Wide-field fundus photograph of an infant: 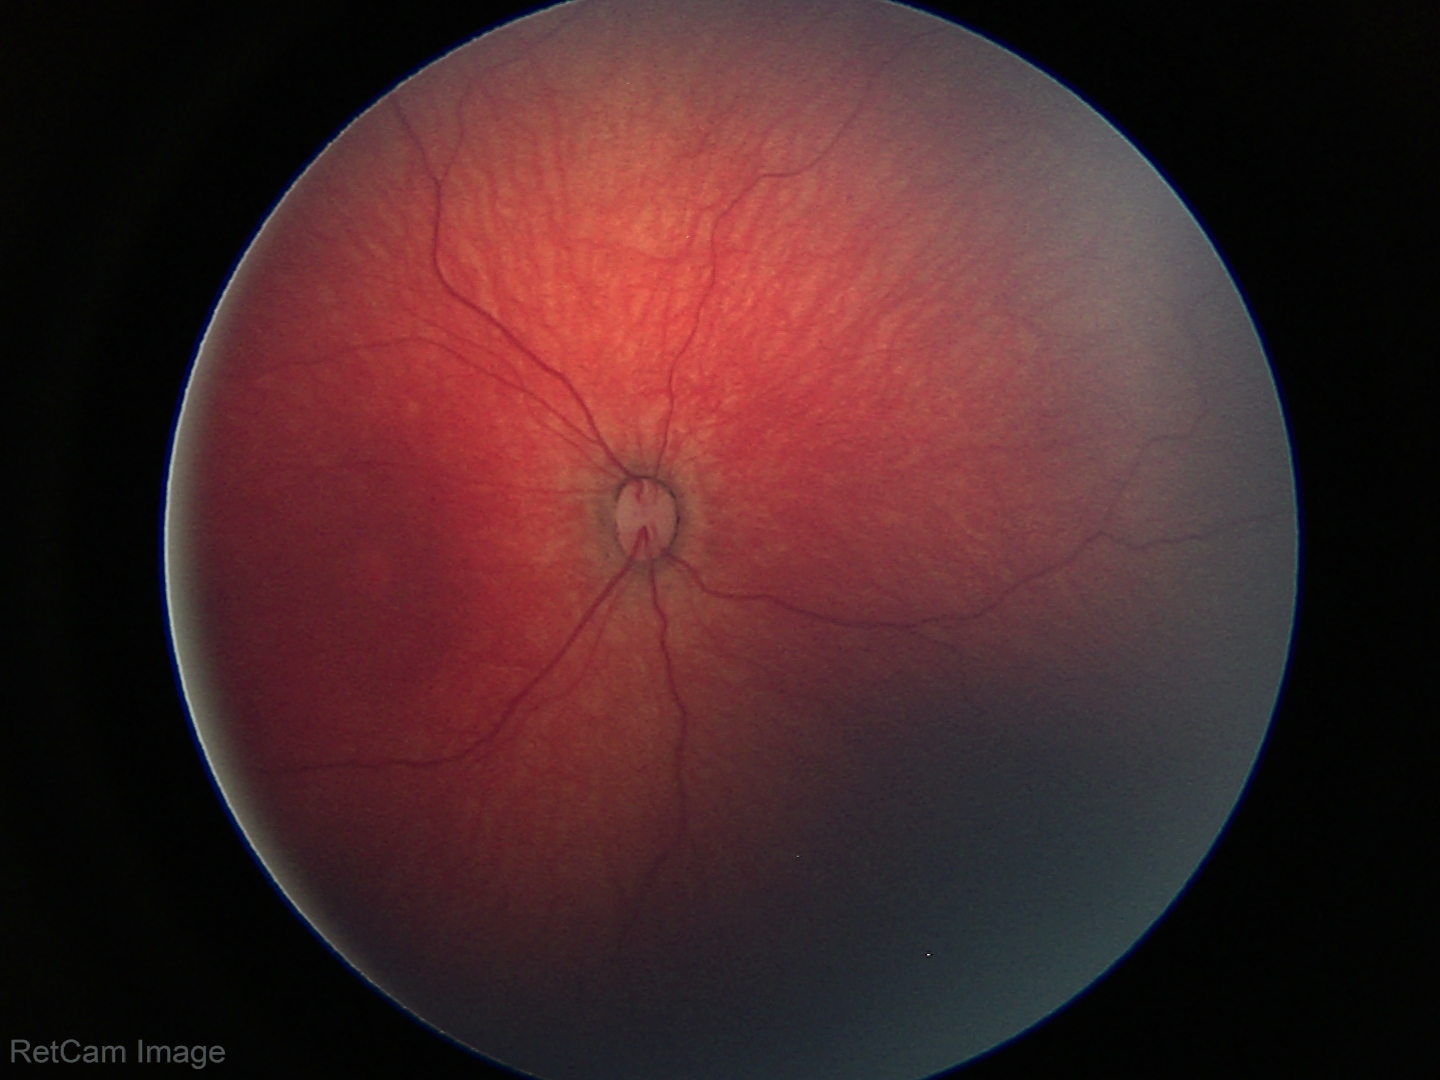

Impression = physiological appearance.